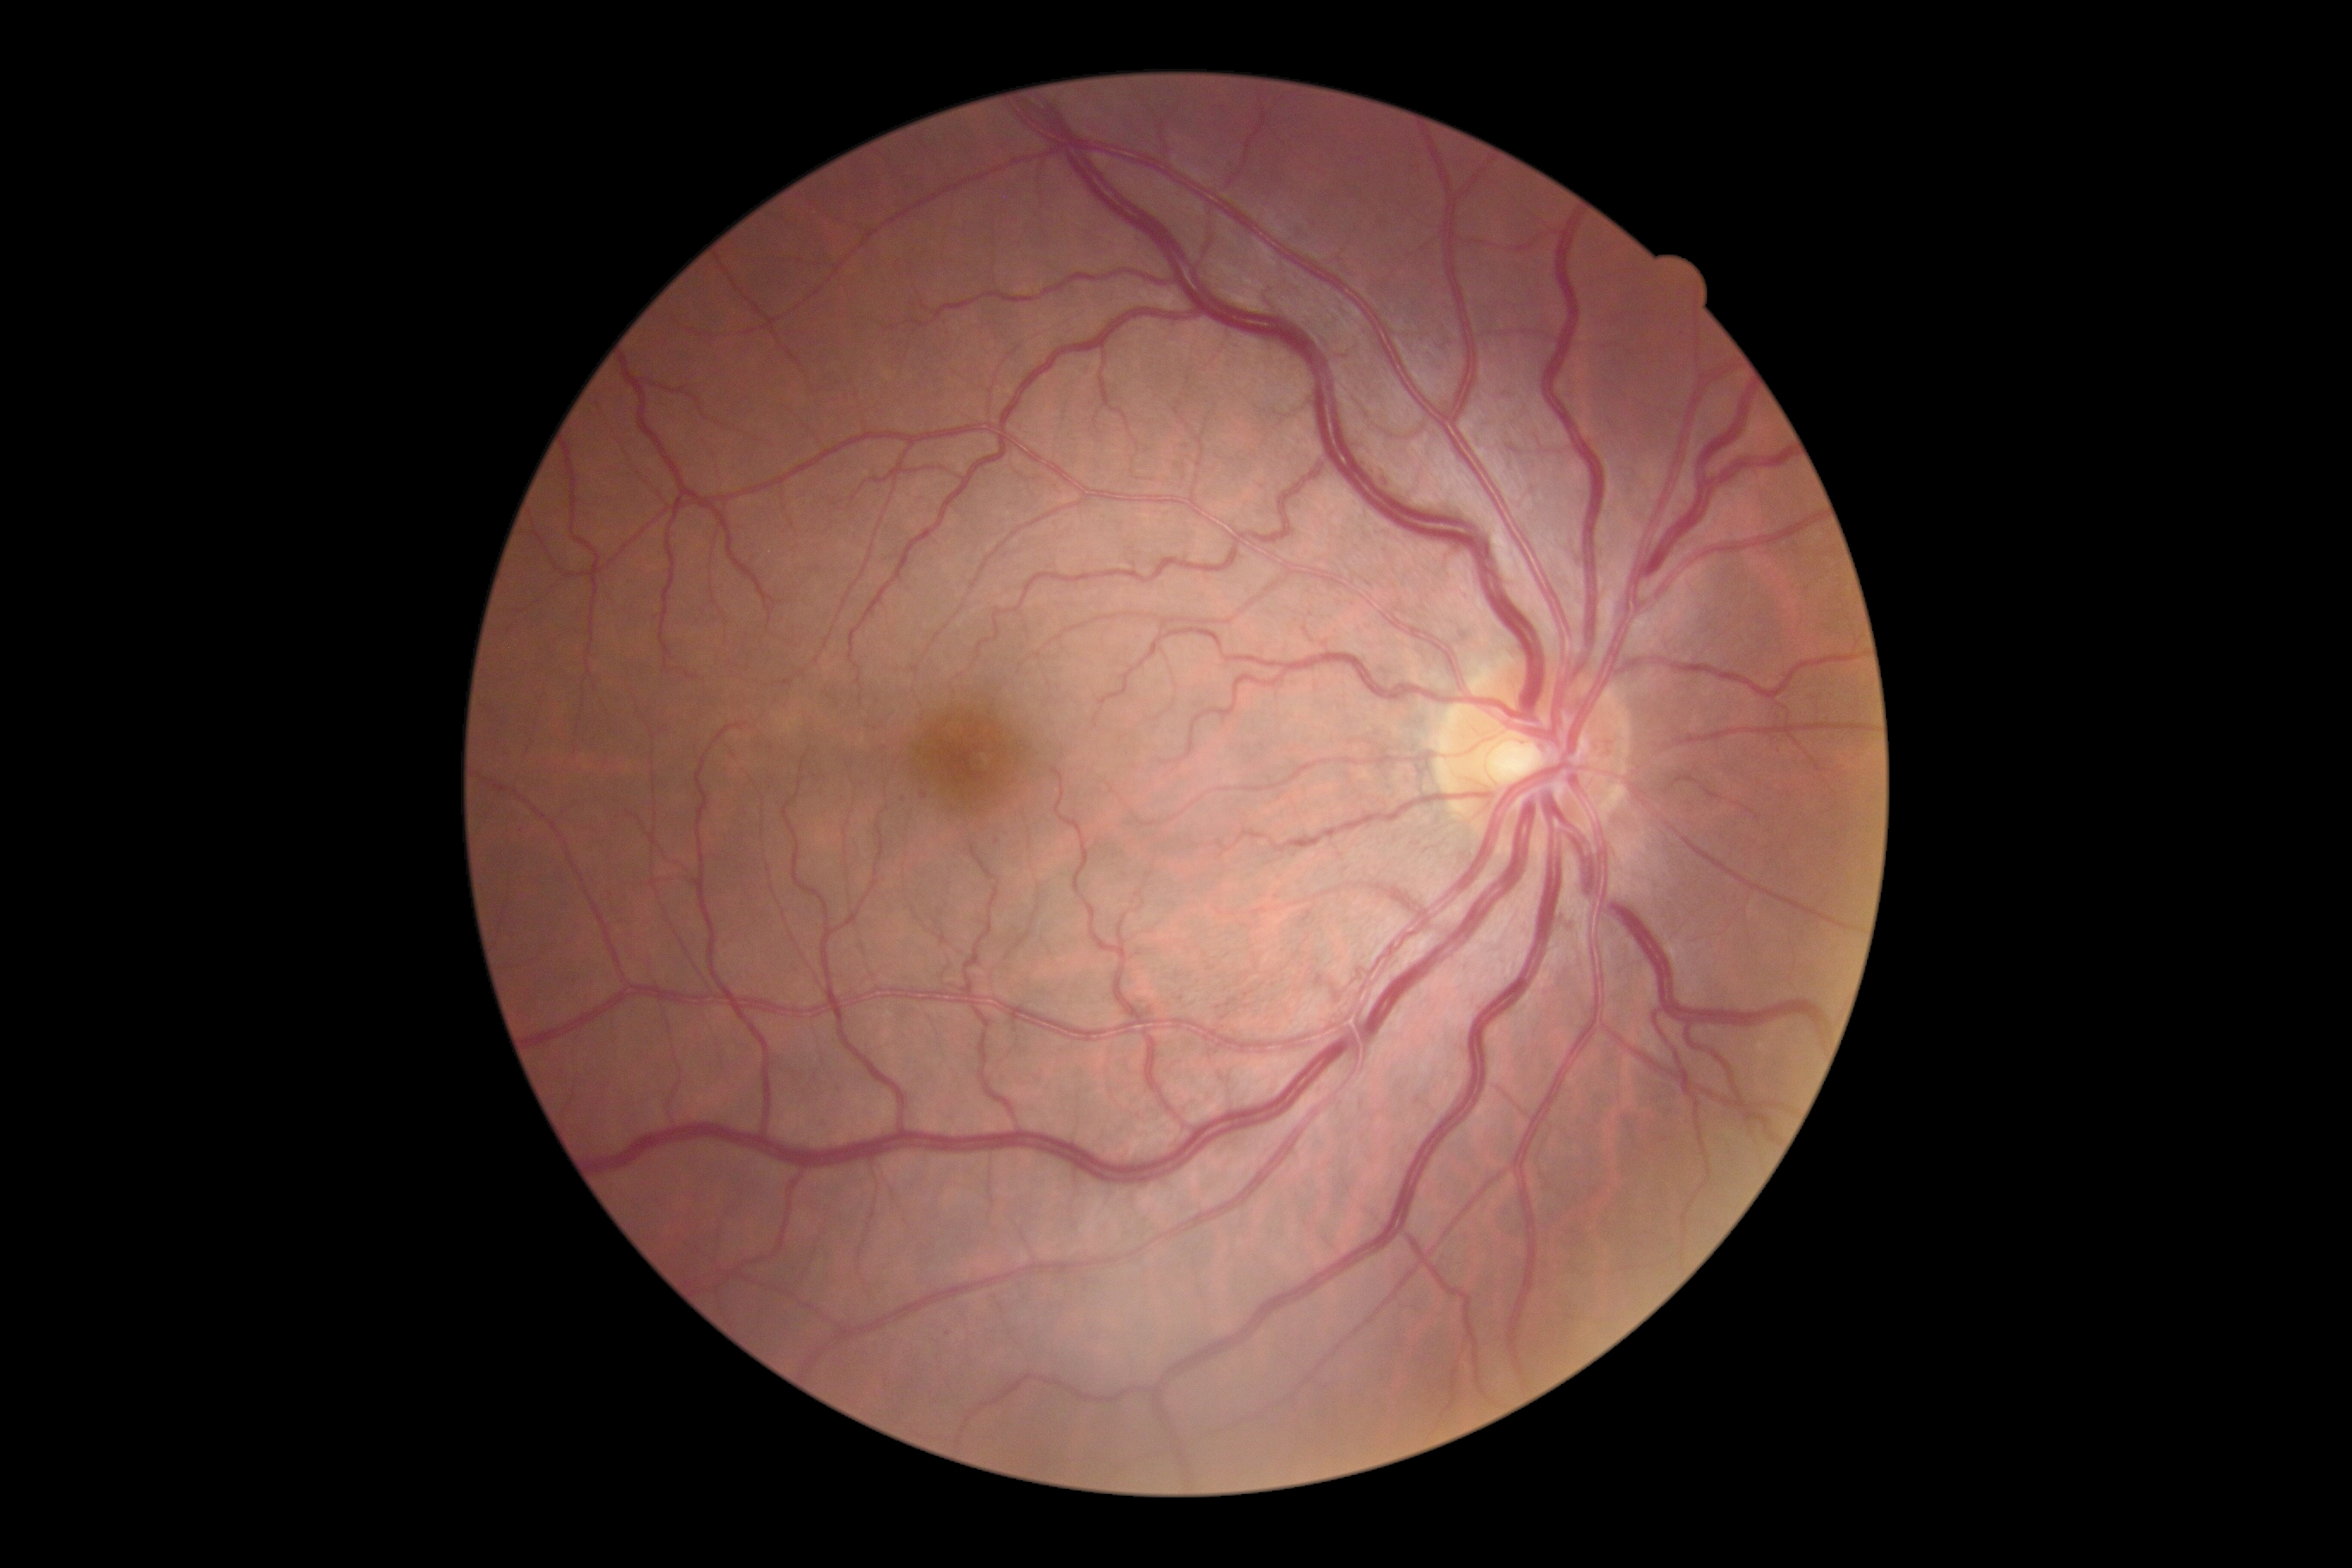
  dr_grade: mild non-proliferative diabetic retinopathy (grade 1)